Cropped from a 35-degree field of view; optic nerve head photograph.
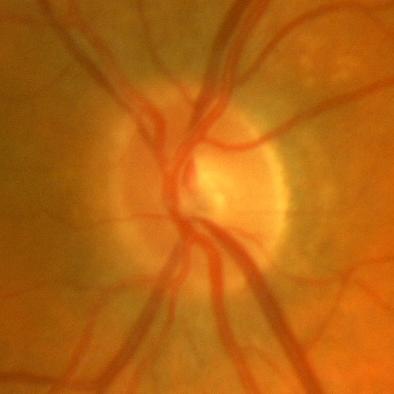

Glaucoma status = no glaucomatous changes.